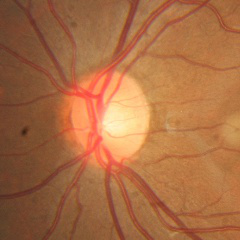
Diagnosis = no glaucomatous changes.